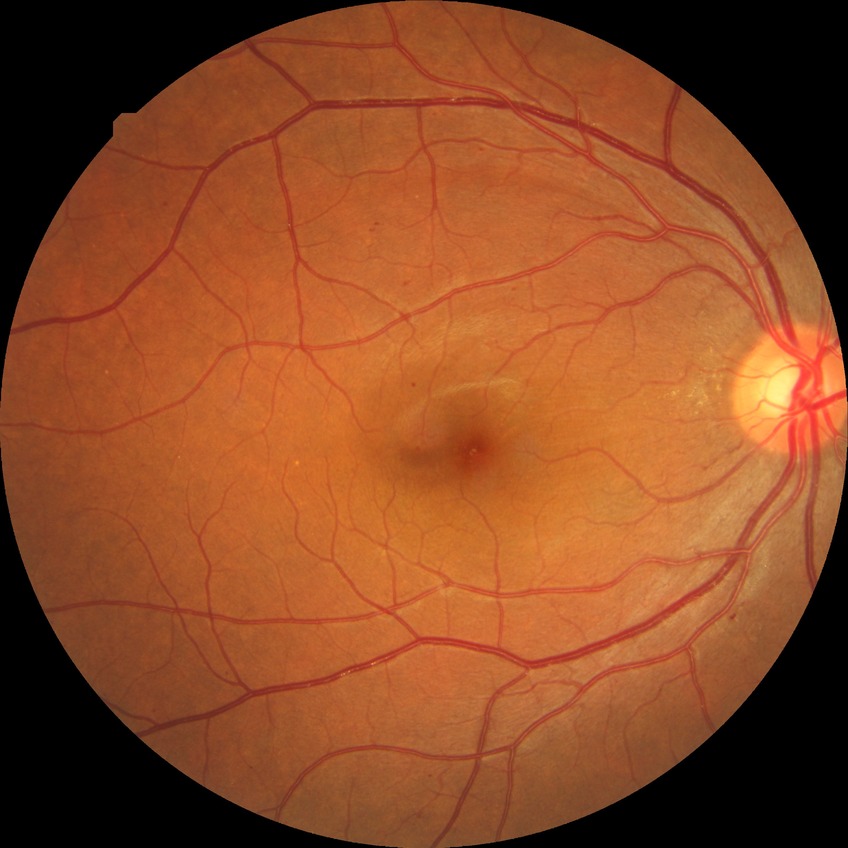
Annotations:
– DR class — non-proliferative diabetic retinopathy
– DR stage — SDR